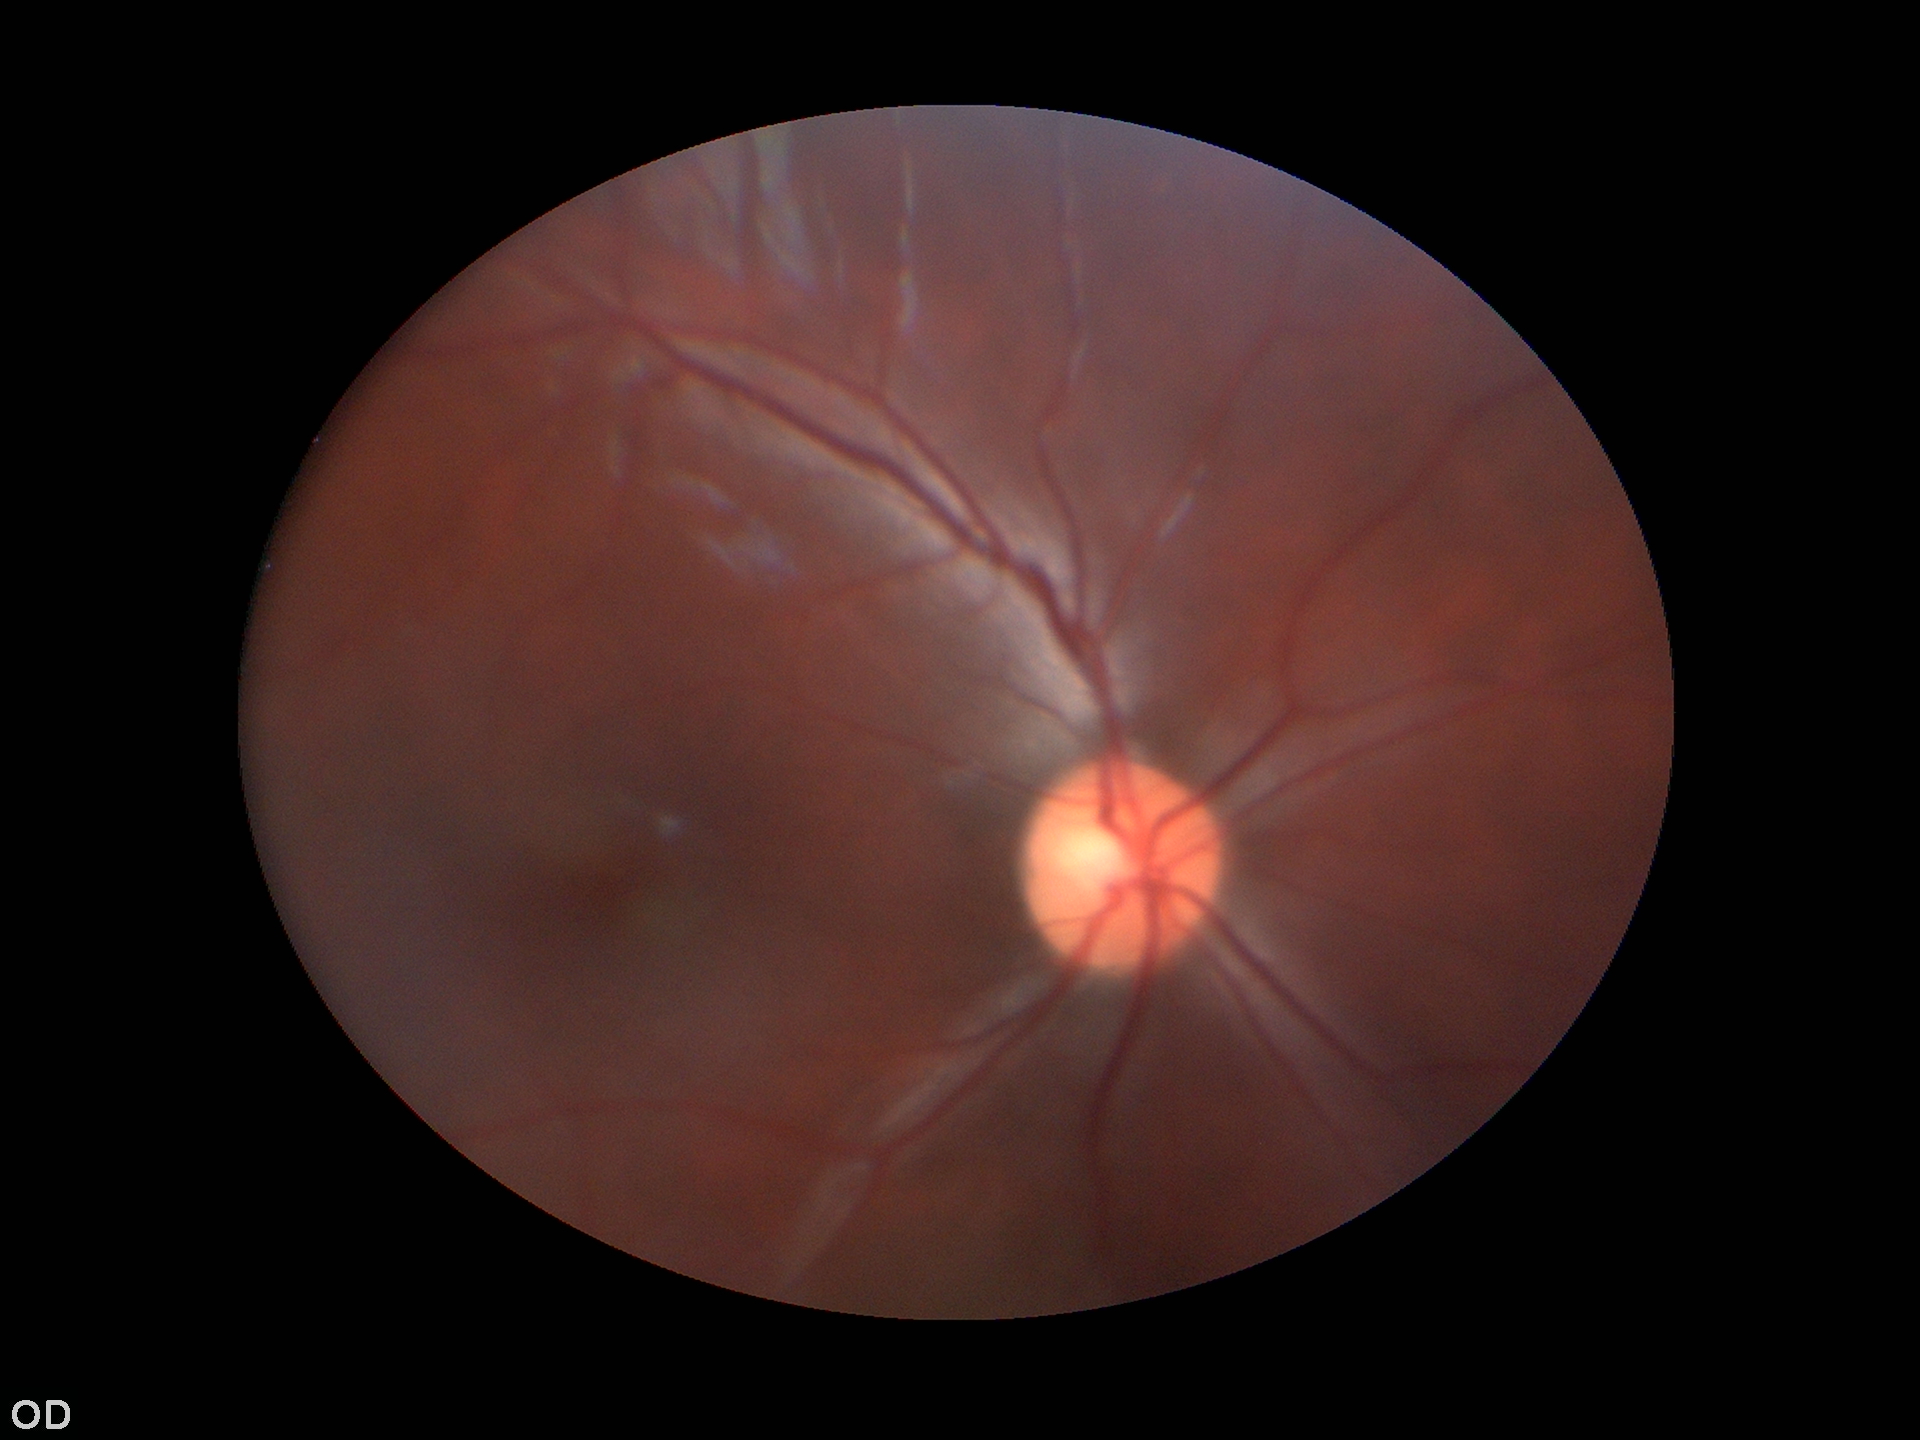
No glaucomatous findings.
Vertical C/D ratio (VCDR) is 0.46.
Area cup-to-disc ratio (ACDR): 0.22.
Horizontal cup-disc ratio (HCDR) is 0.49.